Image size 2352x1568, color fundus image, 45° field of view — 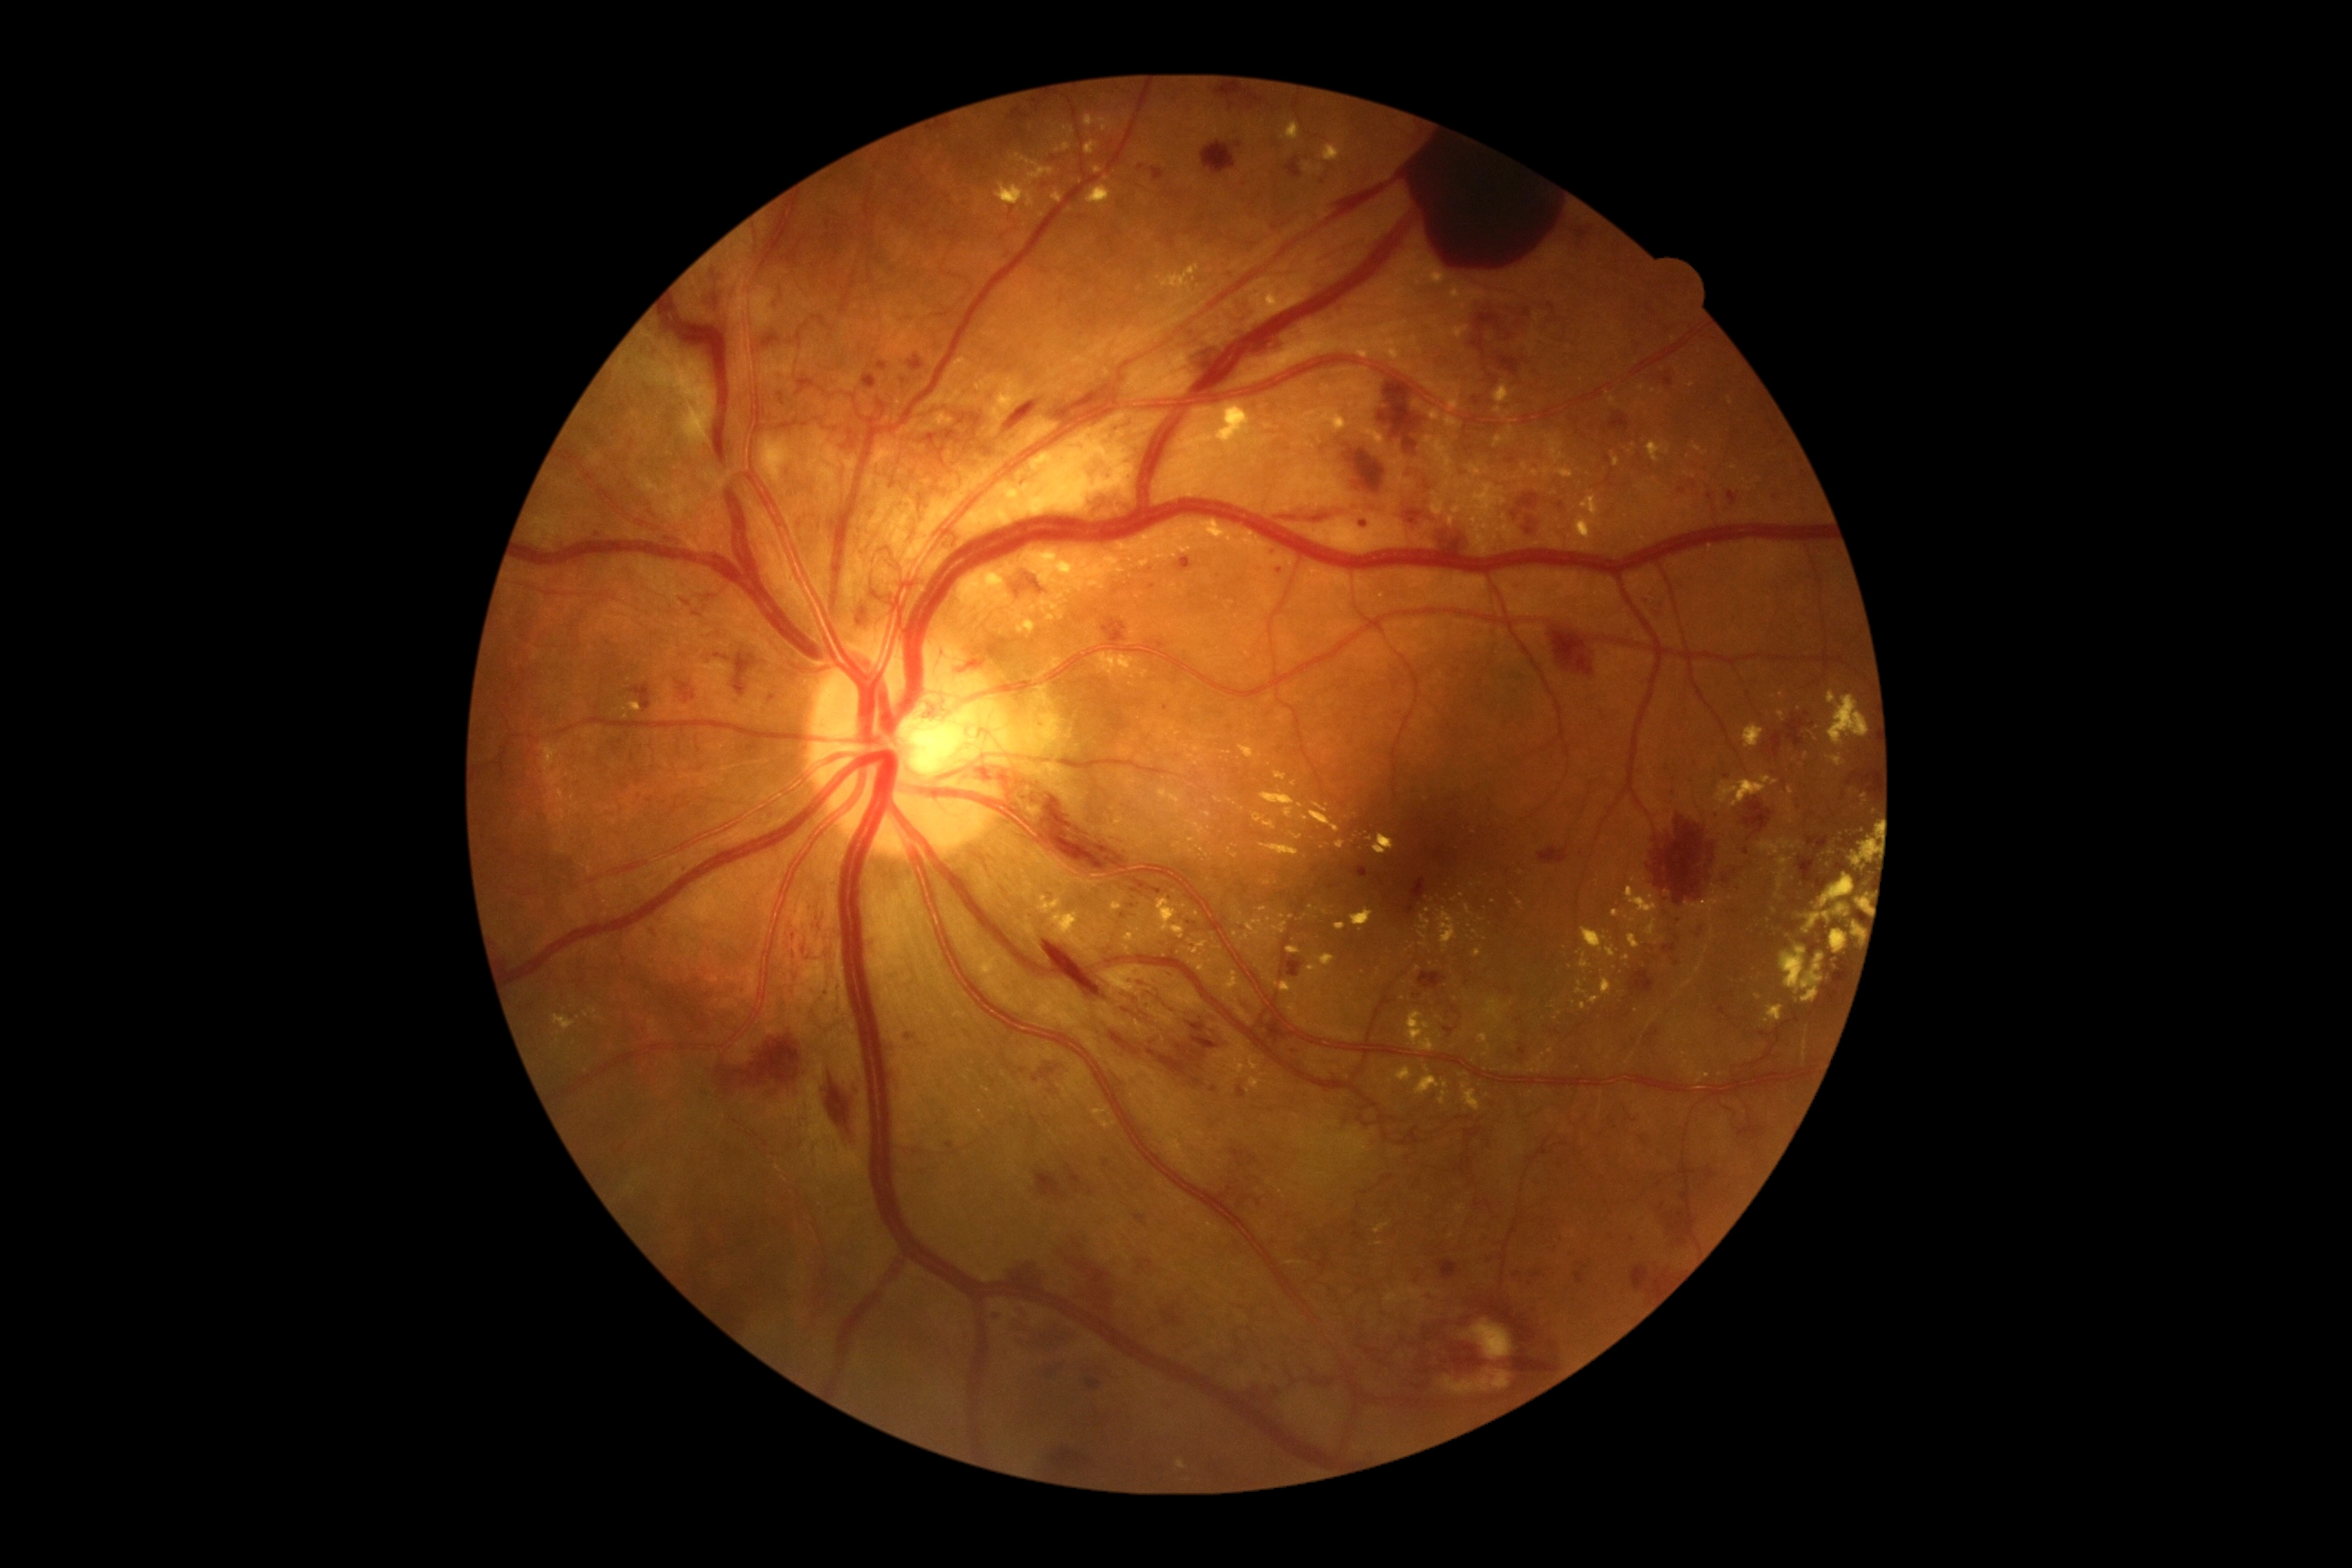 partial: true
dr_grade: 4
dr_grade_name: PDR
lesions:
  he:
    - 1208 1357 1228 1375
    - 1667 1204 1690 1246
    - 631 683 652 712
    - 1084 487 1139 518
    - 1012 1302 1073 1357
    - 863 377 877 389
    - 1740 848 1754 858
    - 1004 400 1041 433
    - 1574 1271 1585 1286
    - 1035 721 1046 729
    - 1237 1202 1244 1210
    - 1473 398 1482 406
    - 796 377 818 398
    - 1836 859 1854 874
  he_small:
    - [1642,1139]
    - [1727,911]
    - [1632,1240]
    - [1238,147]
  ex:
    - 1157 789 1186 816
    - 1037 896 1063 916
    - 1396 1068 1413 1083
    - 1097 652 1148 680
    - 1612 453 1620 467
    - 975 375 1024 422
    - 1064 126 1075 137
    - 1139 560 1150 567
    - 1250 1055 1260 1072
    - 1830 930 1848 954
  ex_small:
    - [1260,756]
    - [1380,1244]
    - [1236,934]
    - [1427,1069]
    - [1060,597]
    - [1485,1055]
    - [1312,908]
    - [1423,945]